45-degree field of view:
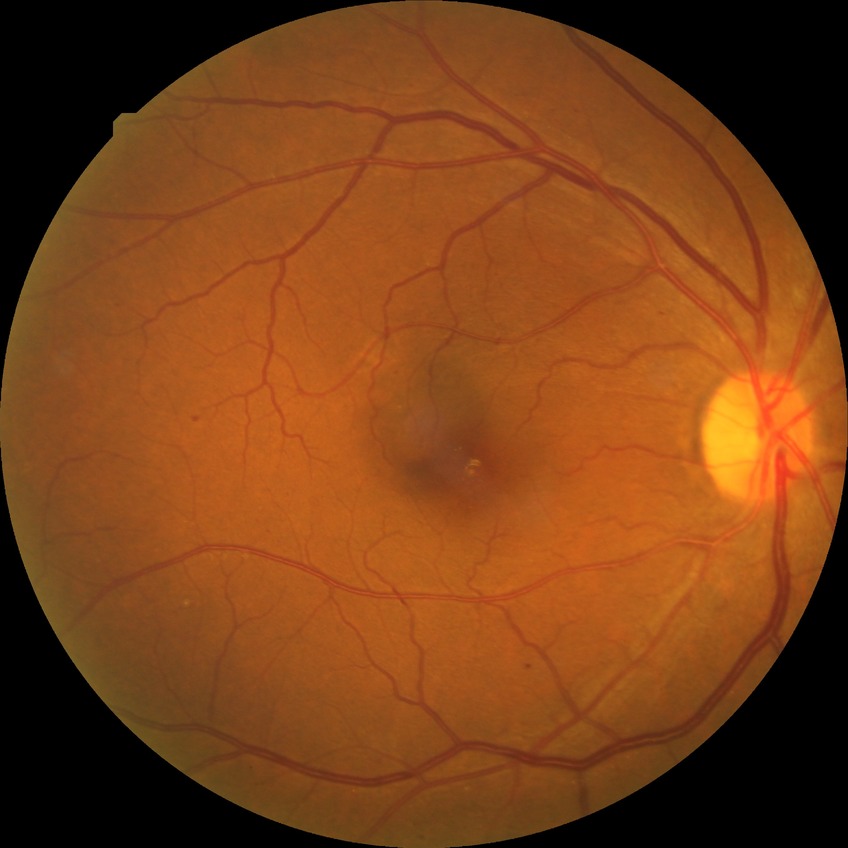

{
  "davis_grade": "SDR (simple diabetic retinopathy)"
}